1960x1897px: 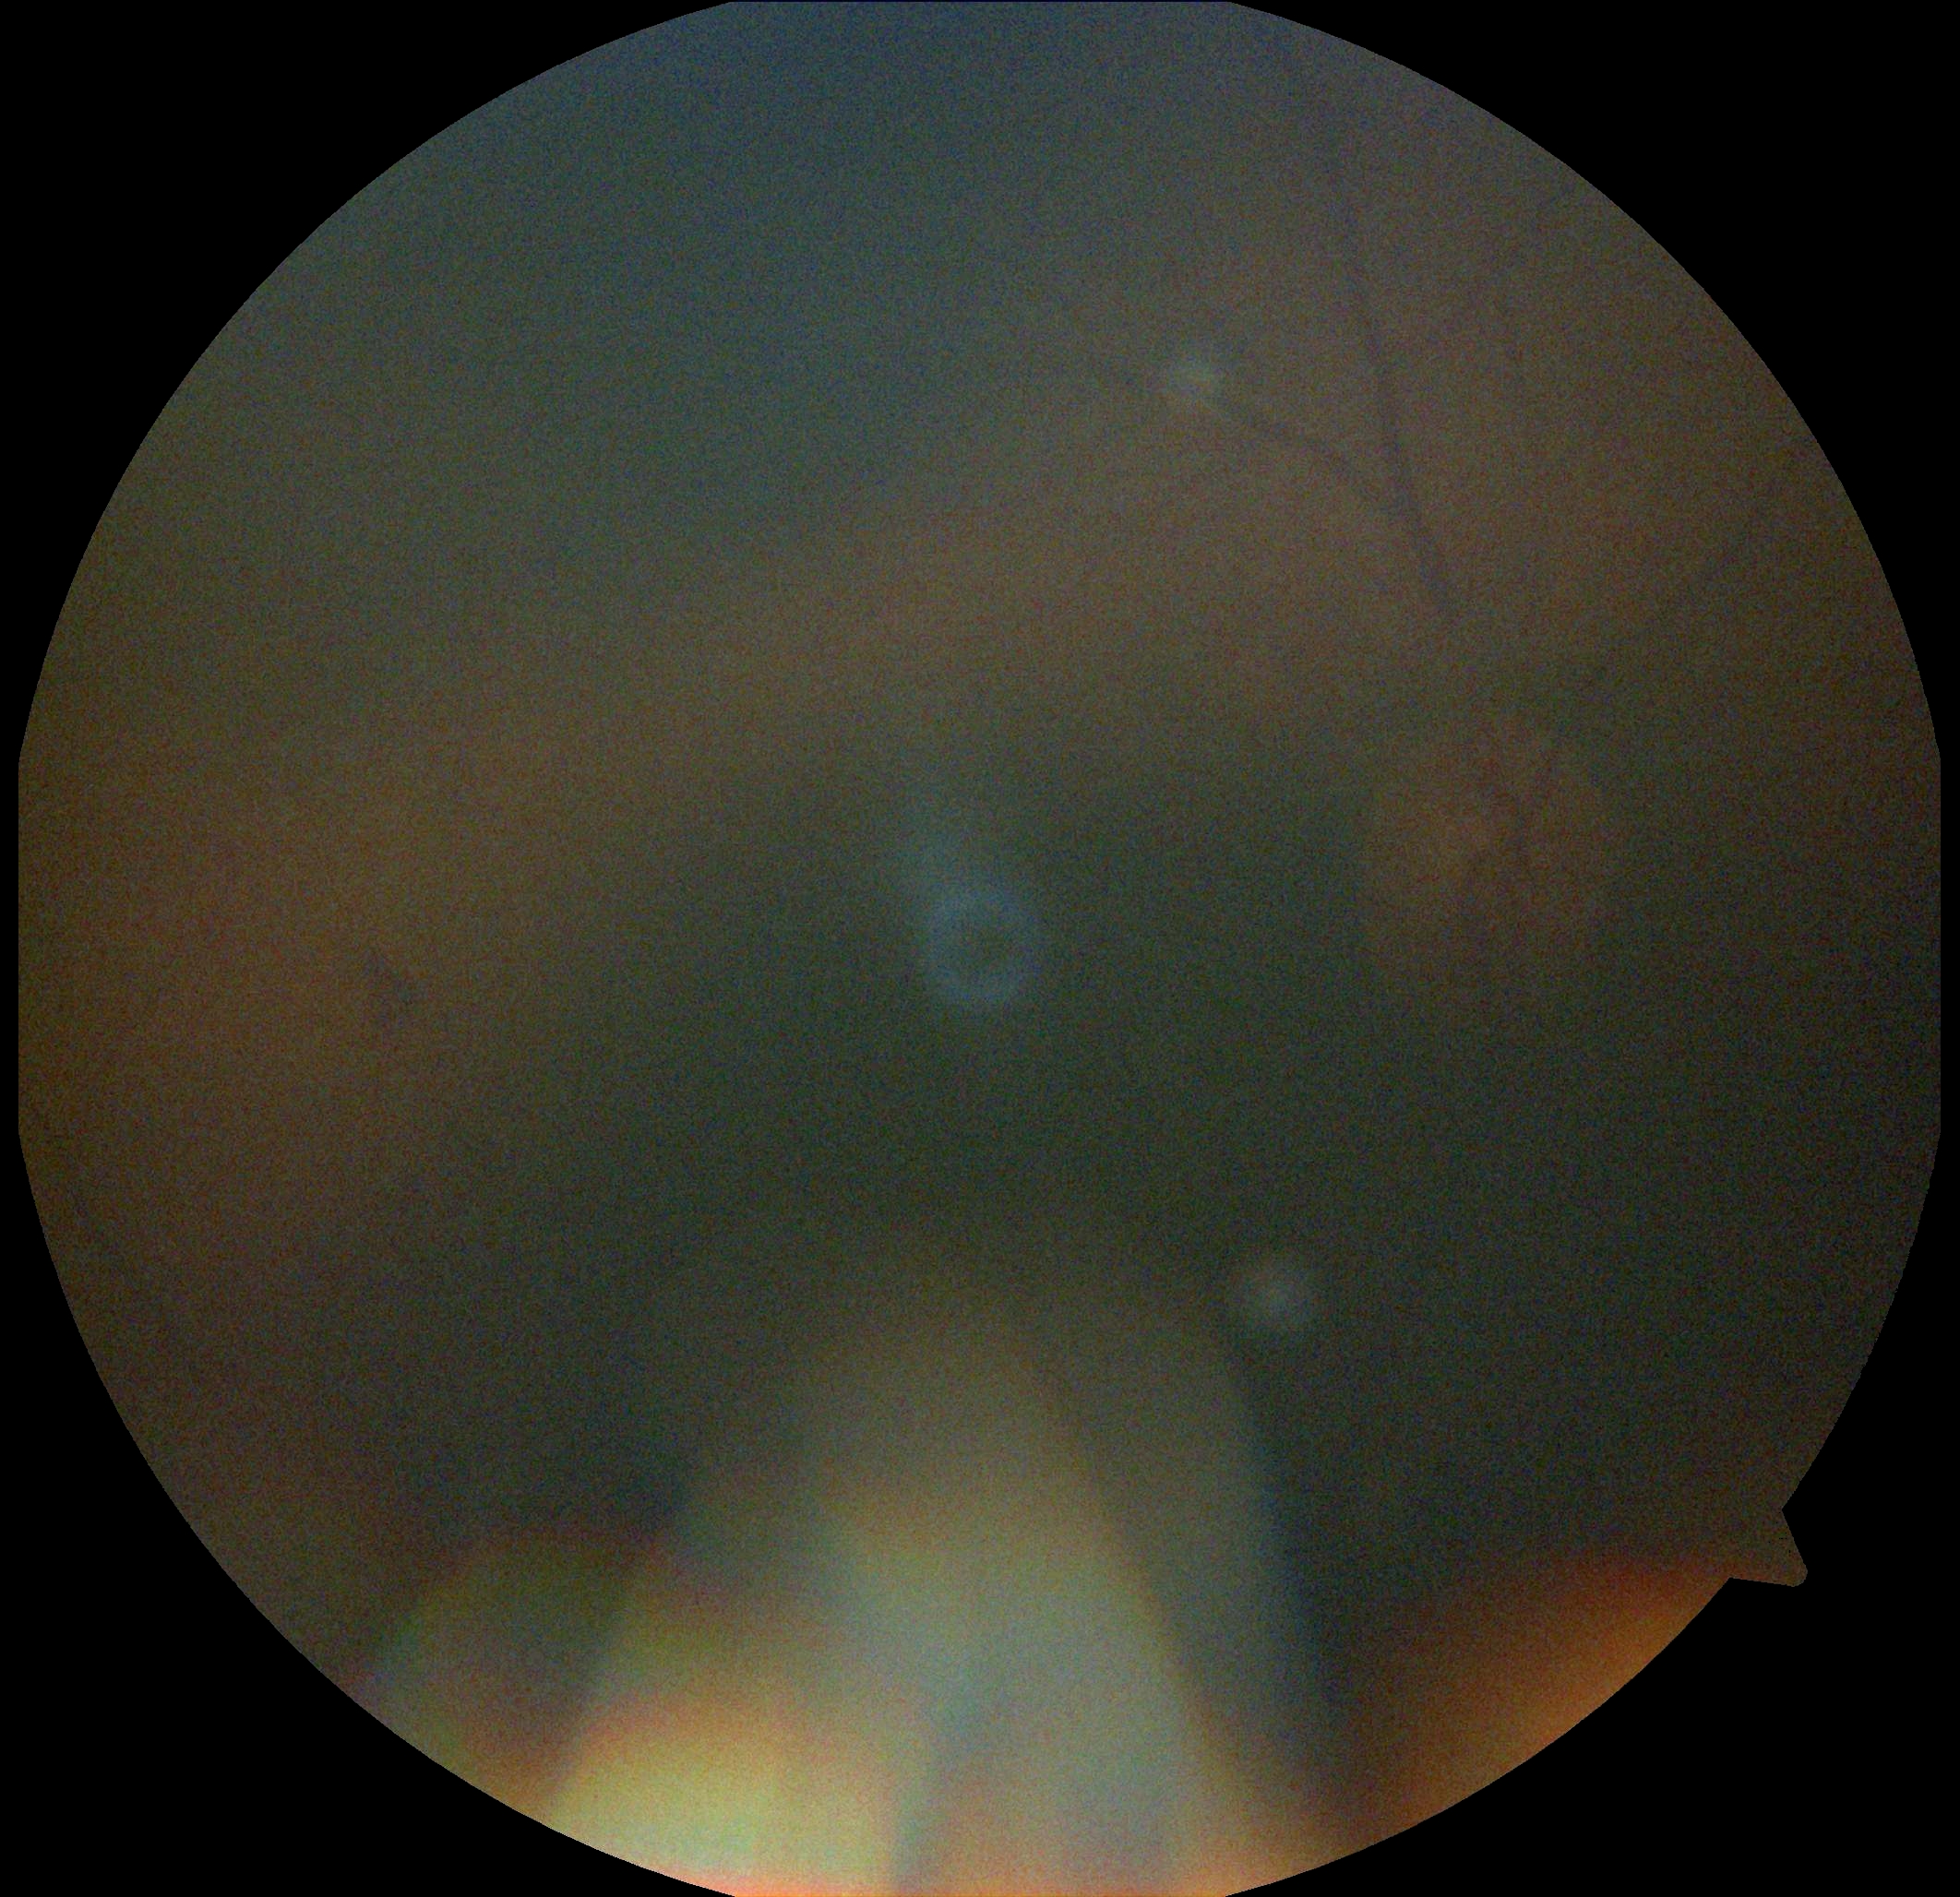   dr_grade: ungradable due to poor image quality
  quality: below grading threshold